Fundus photo; 2361x1568px; centered on the macula; 50° field of view
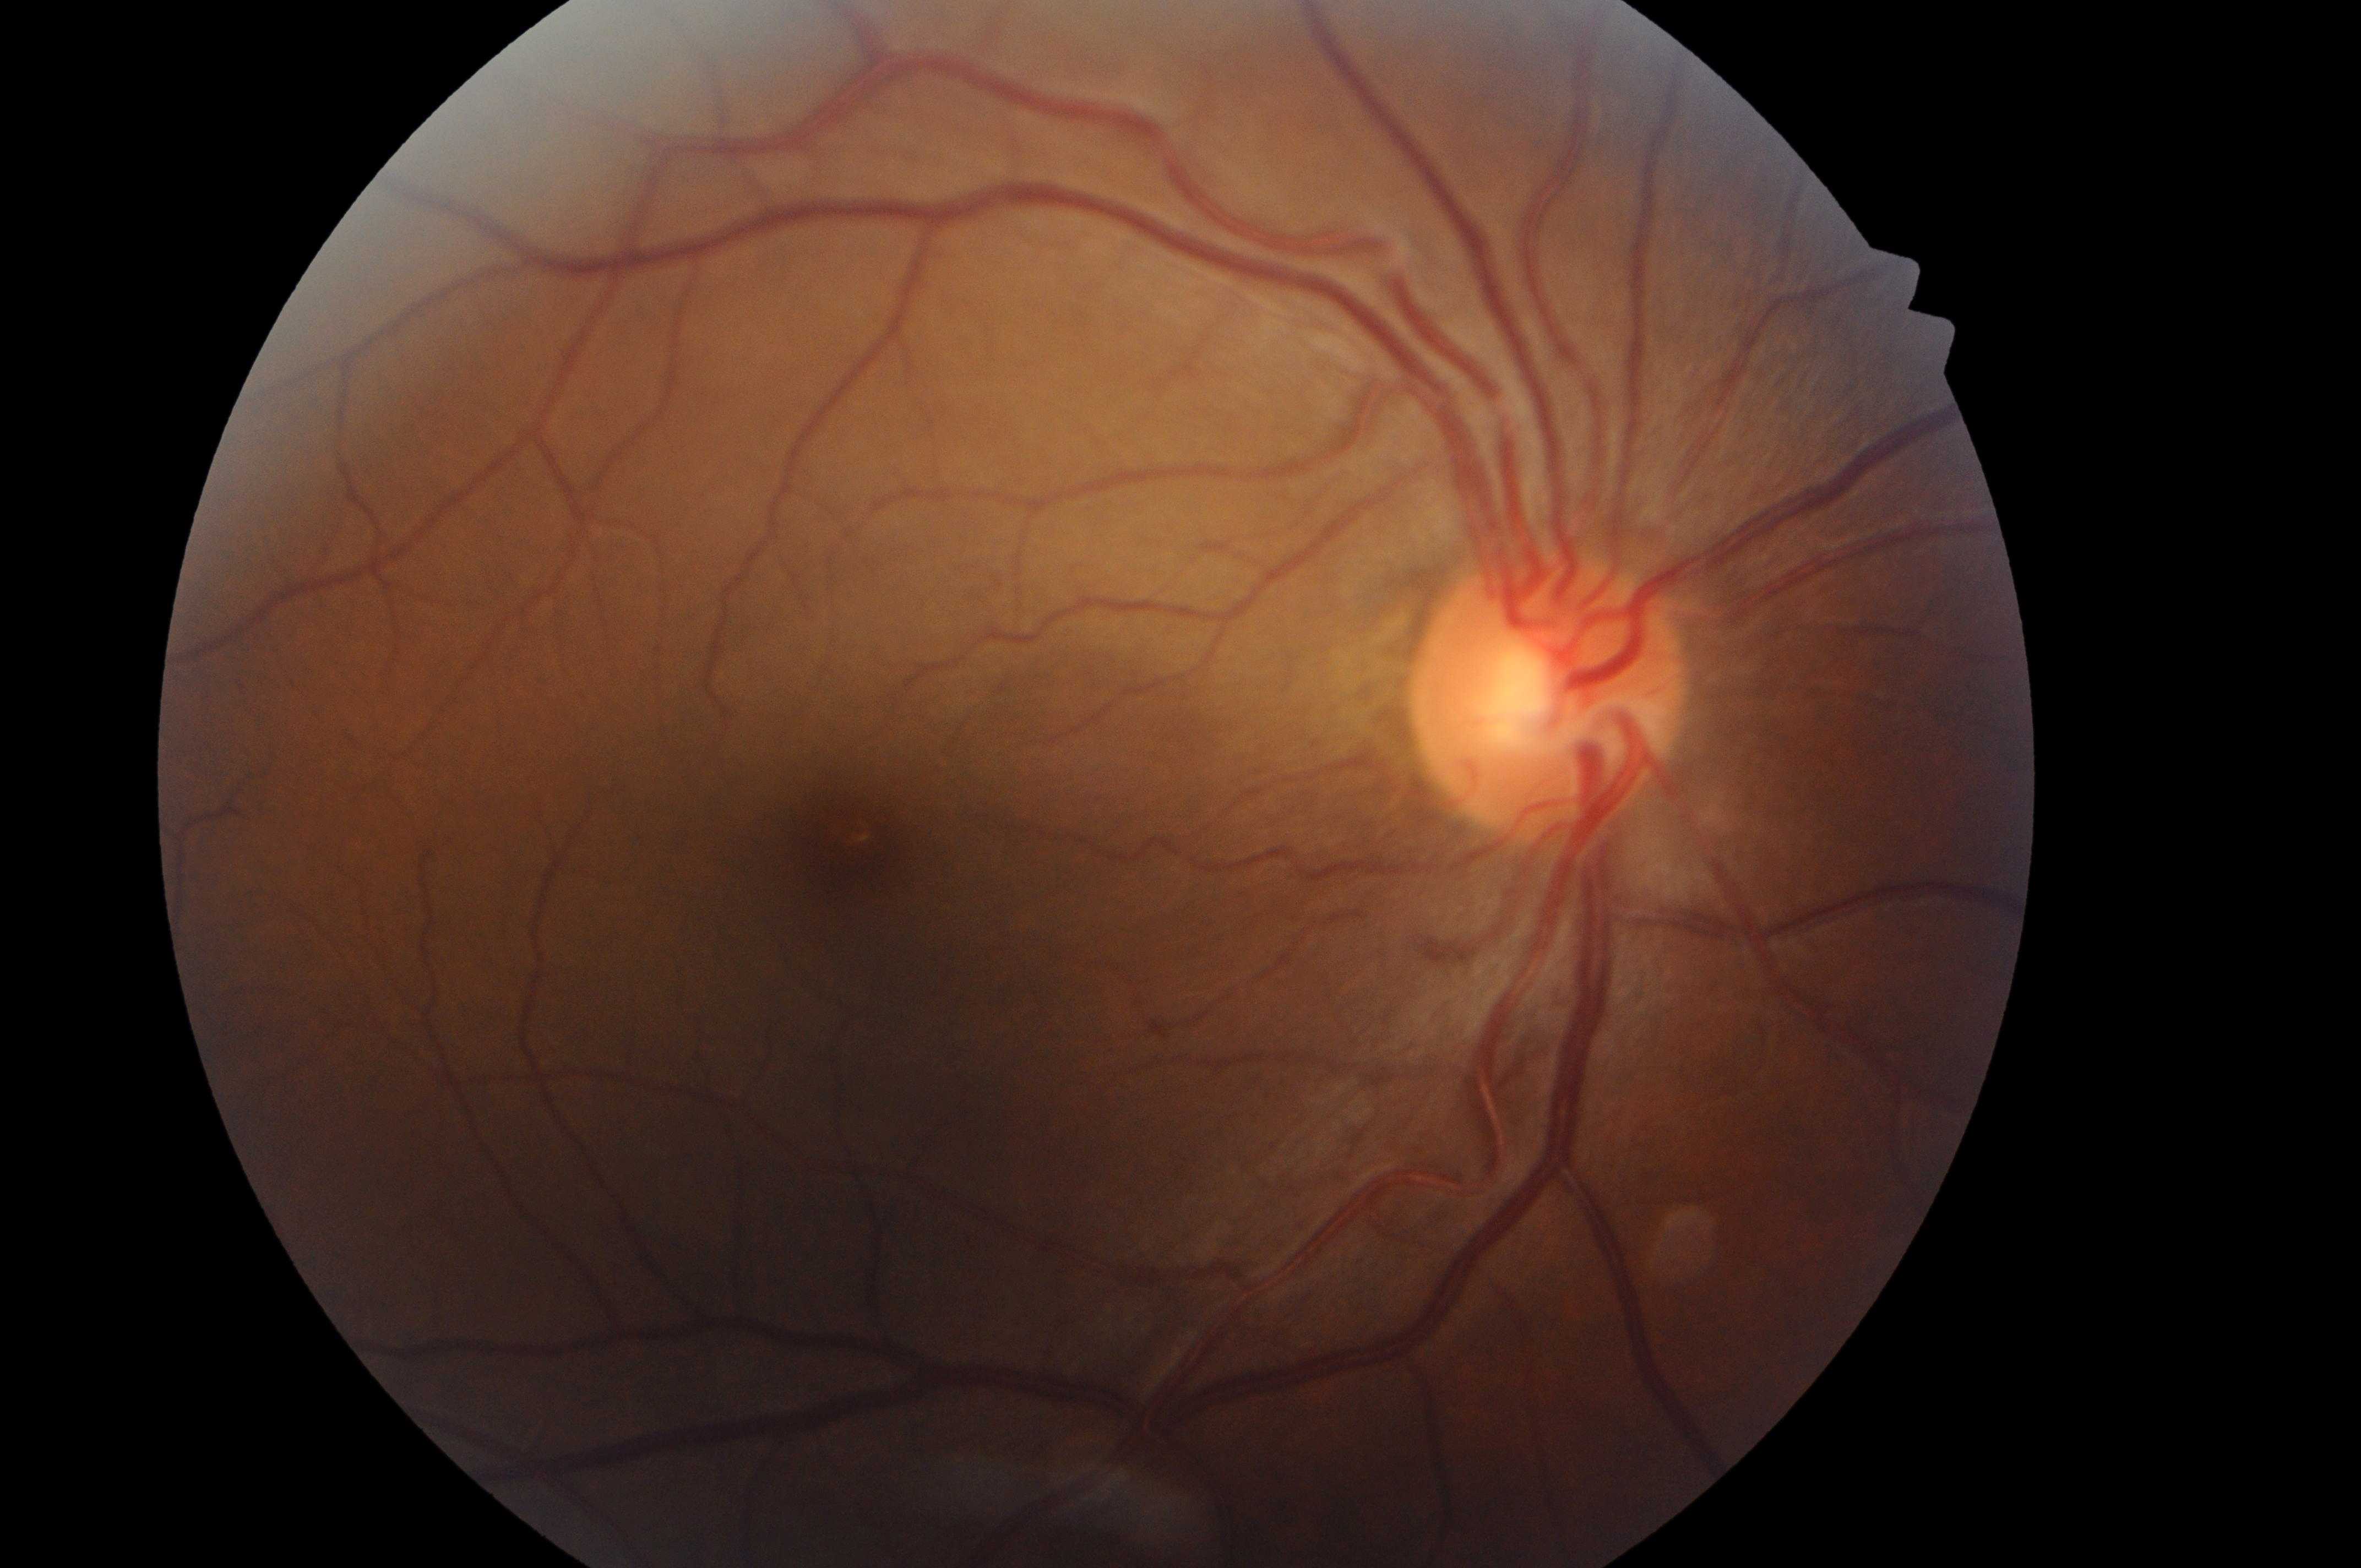

The fovea center is at [844, 847].
Disc center: [1539, 707].
Diabetic retinopathy (DR) is grade 0 (no apparent retinopathy) — no visible signs of diabetic retinopathy.
This is the oculus dexter.
Diabetic macular edema (DME) is grade 0 (no risk) — no apparent hard exudates.